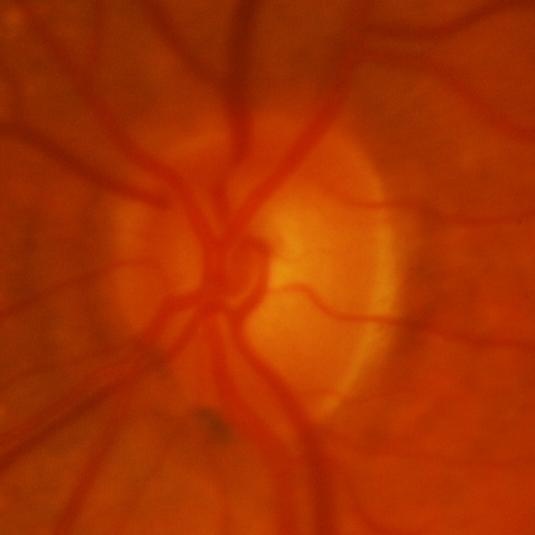
Glaucoma is present.
Evidence of glaucoma.